Wide-field contact fundus photograph of an infant: 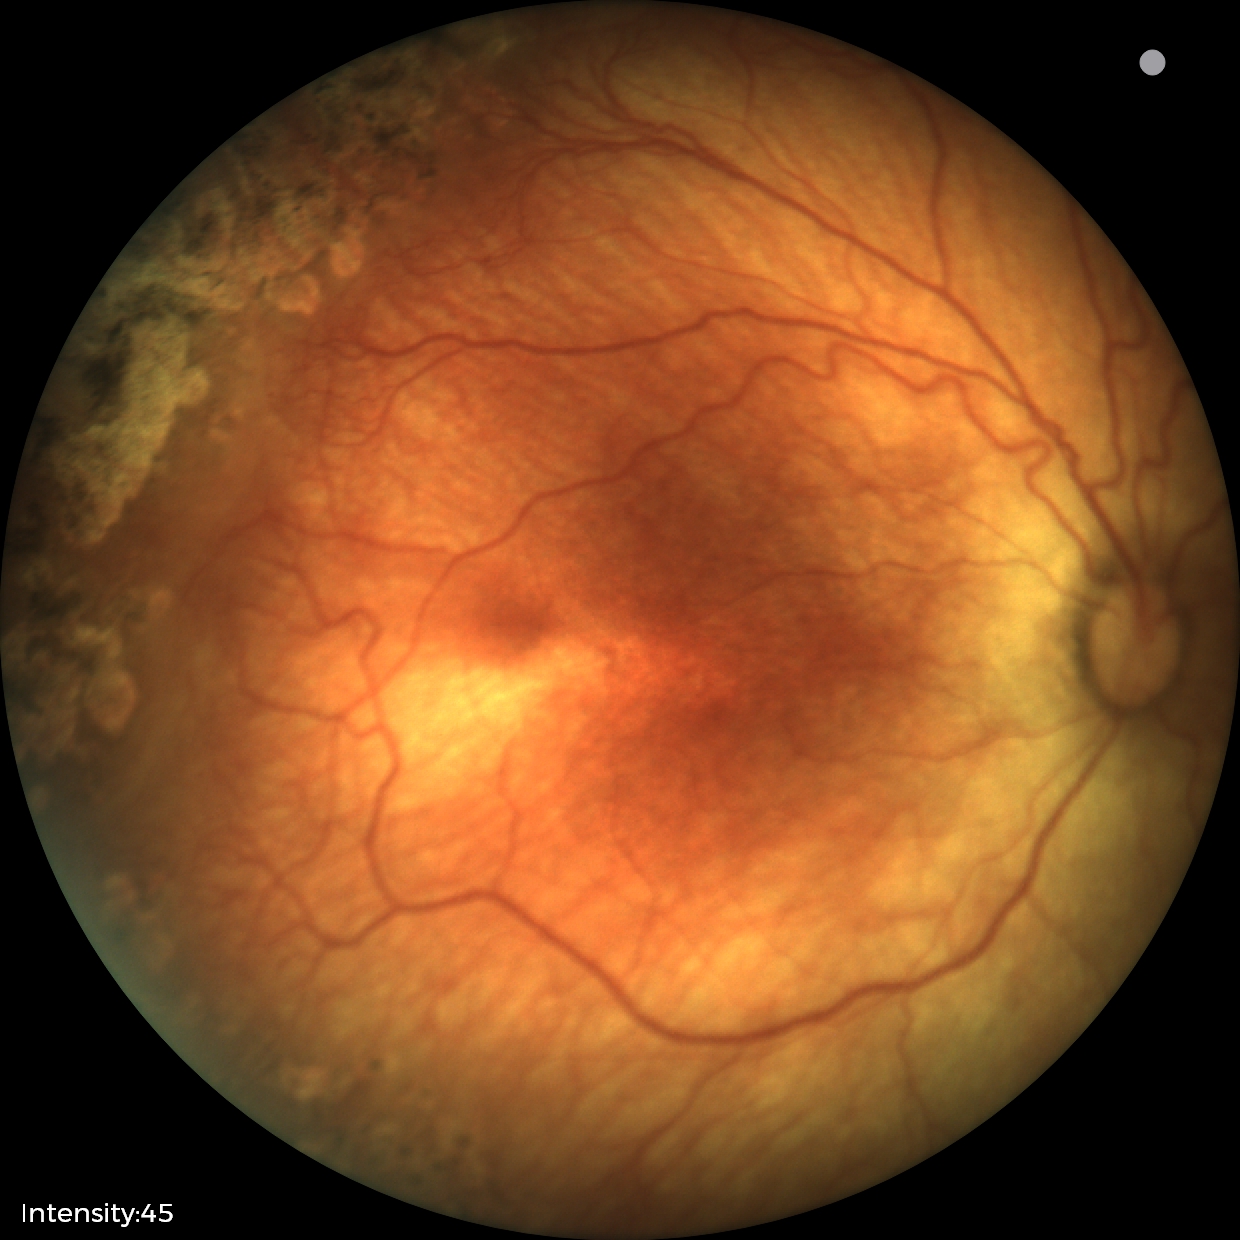
No plus disease.
Diagnosis from this screening exam: status post retinopathy of prematurity (ROP).